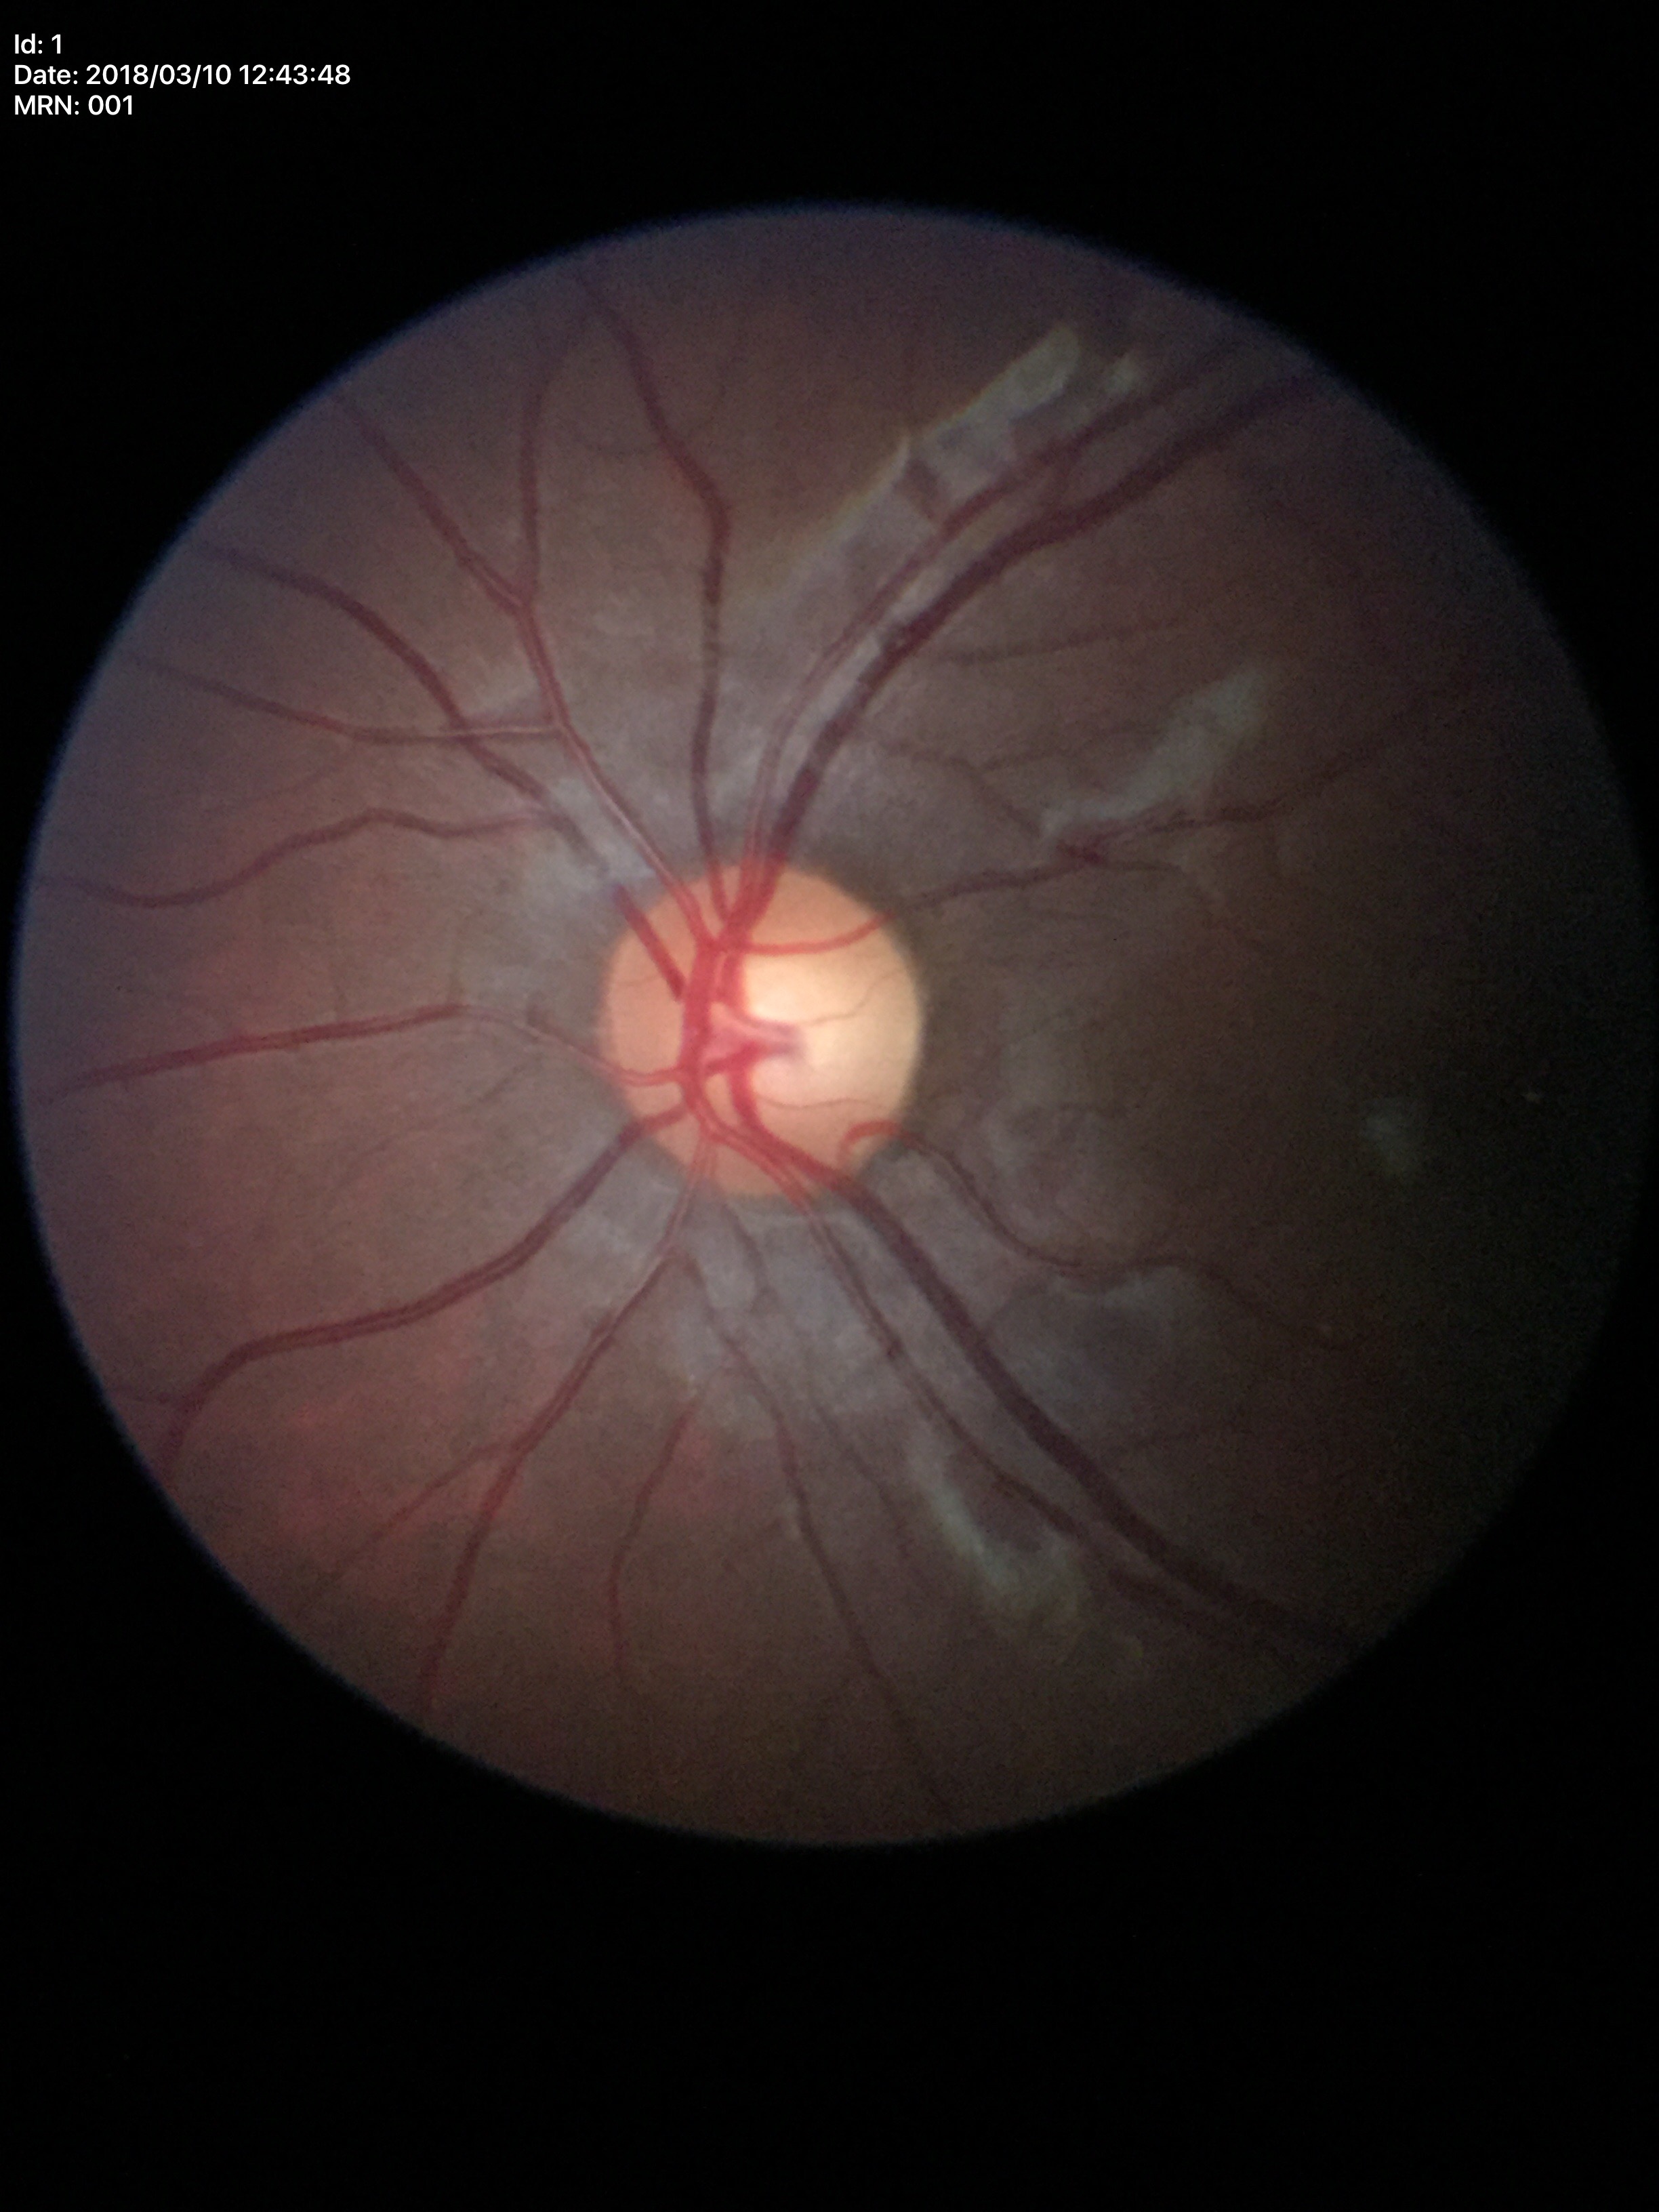 Glaucoma decision=negative | vertical CDR=0.57 | horizontal CDR=0.57